CFP.
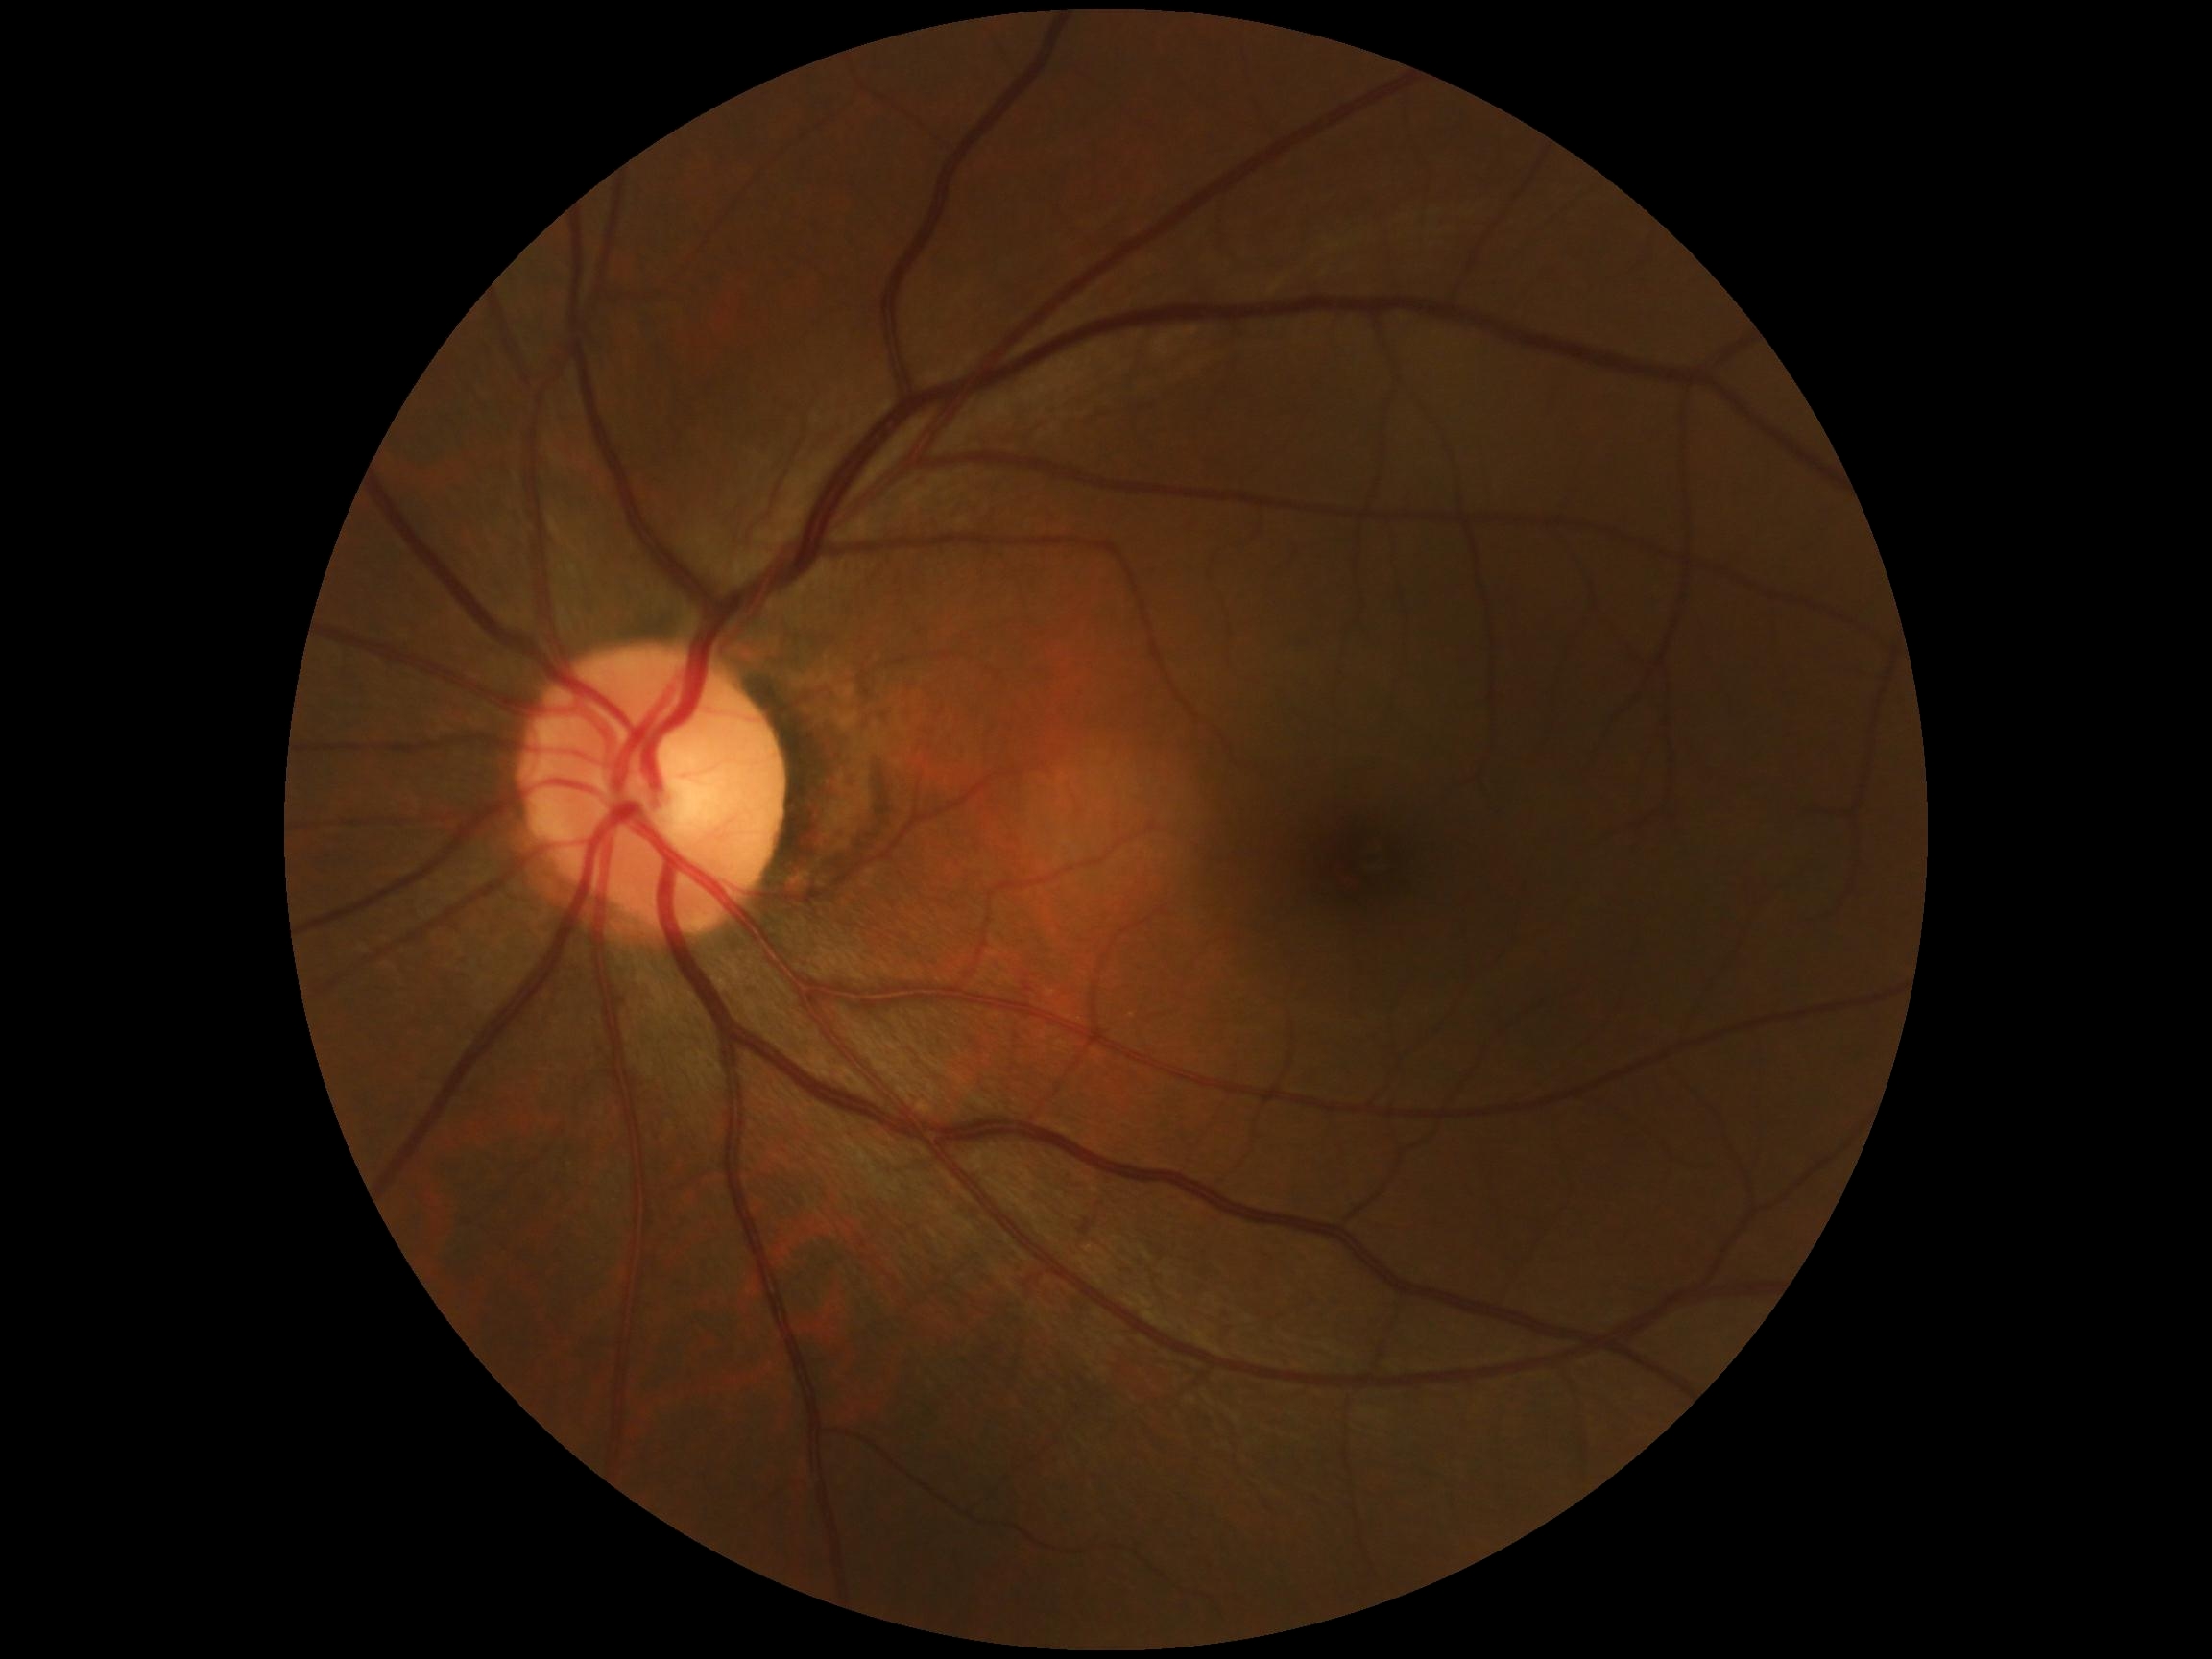 Retinopathy is grade 0 (no apparent retinopathy). No diabetic retinal disease findings.